Graded on the modified Davis scale. Acquired with a NIDEK AFC-230. Without pupil dilation — 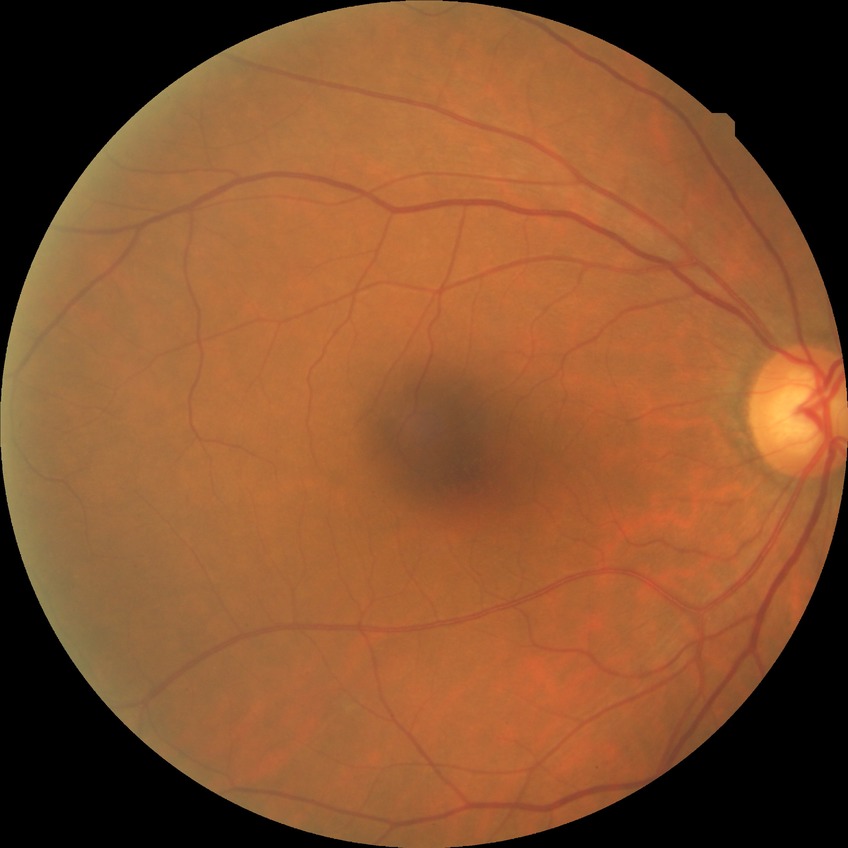
Diabetic retinopathy (DR) is no diabetic retinopathy (NDR).